Pediatric retinal photograph (wide-field); 100° field of view (Phoenix ICON):
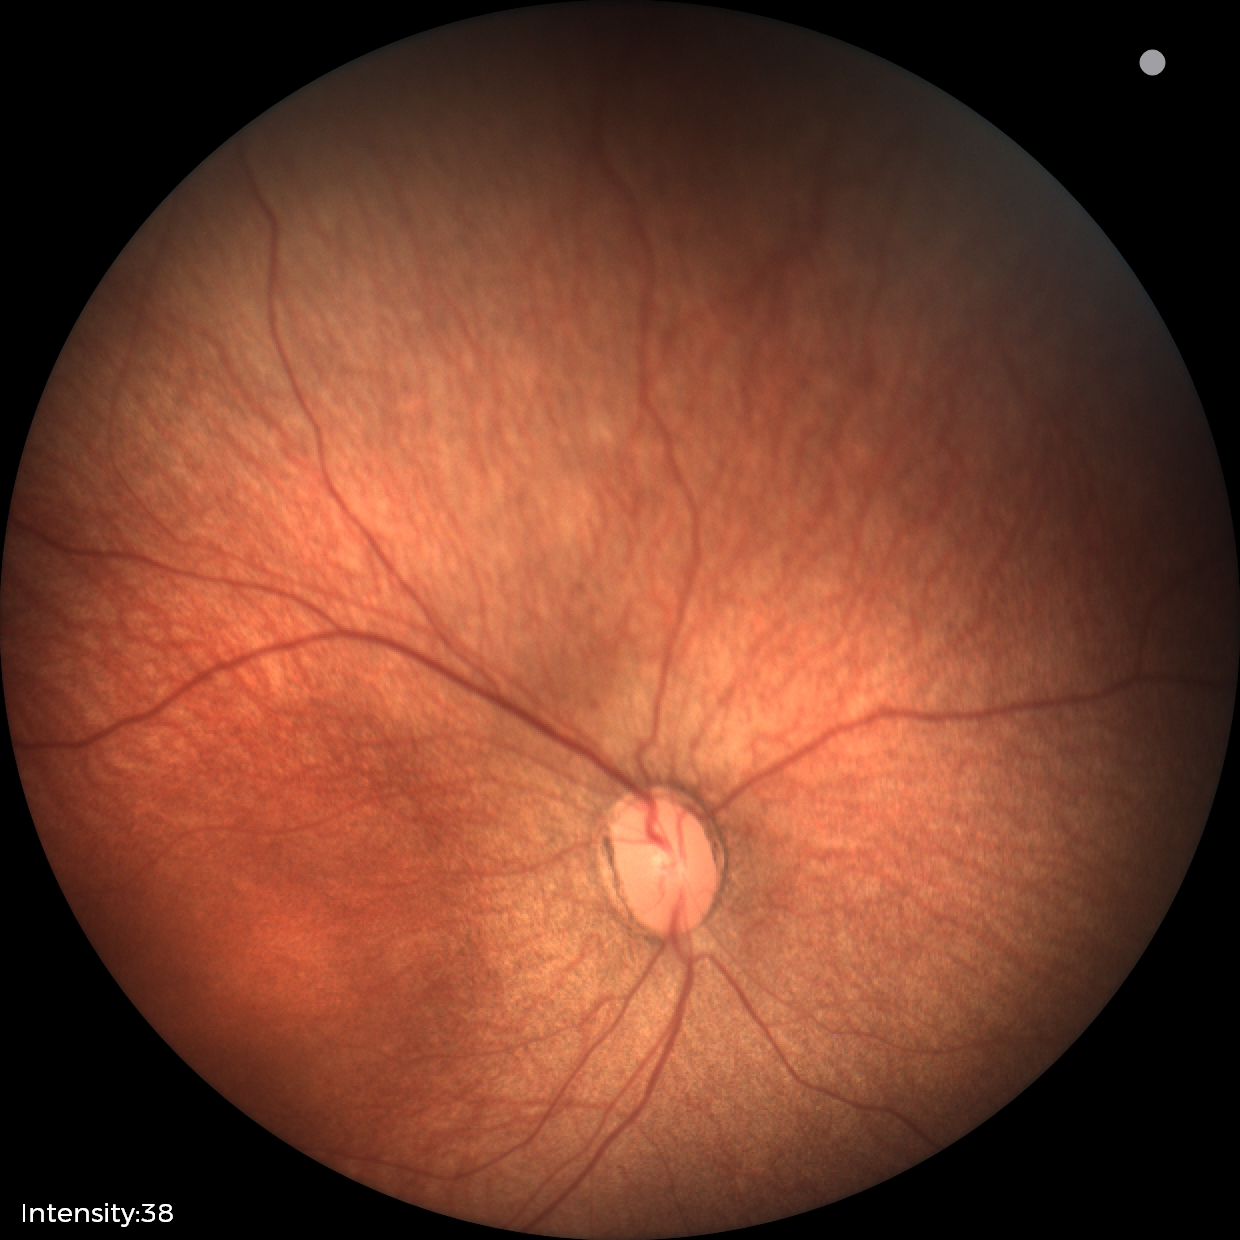
Series diagnosed as status post ROP. Plus disease absent.